DR severity per modified Davis staging · 45 degree fundus photograph · nonmydriatic fundus photograph: 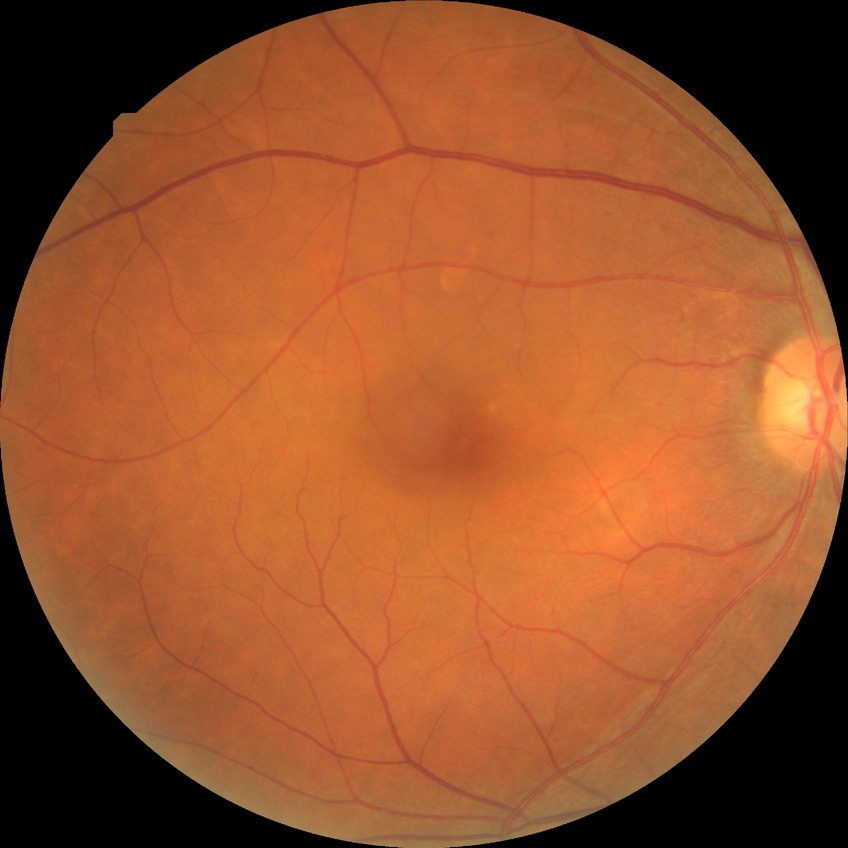
Findings:
• diabetic retinopathy stage — no diabetic retinopathy